Color fundus image — 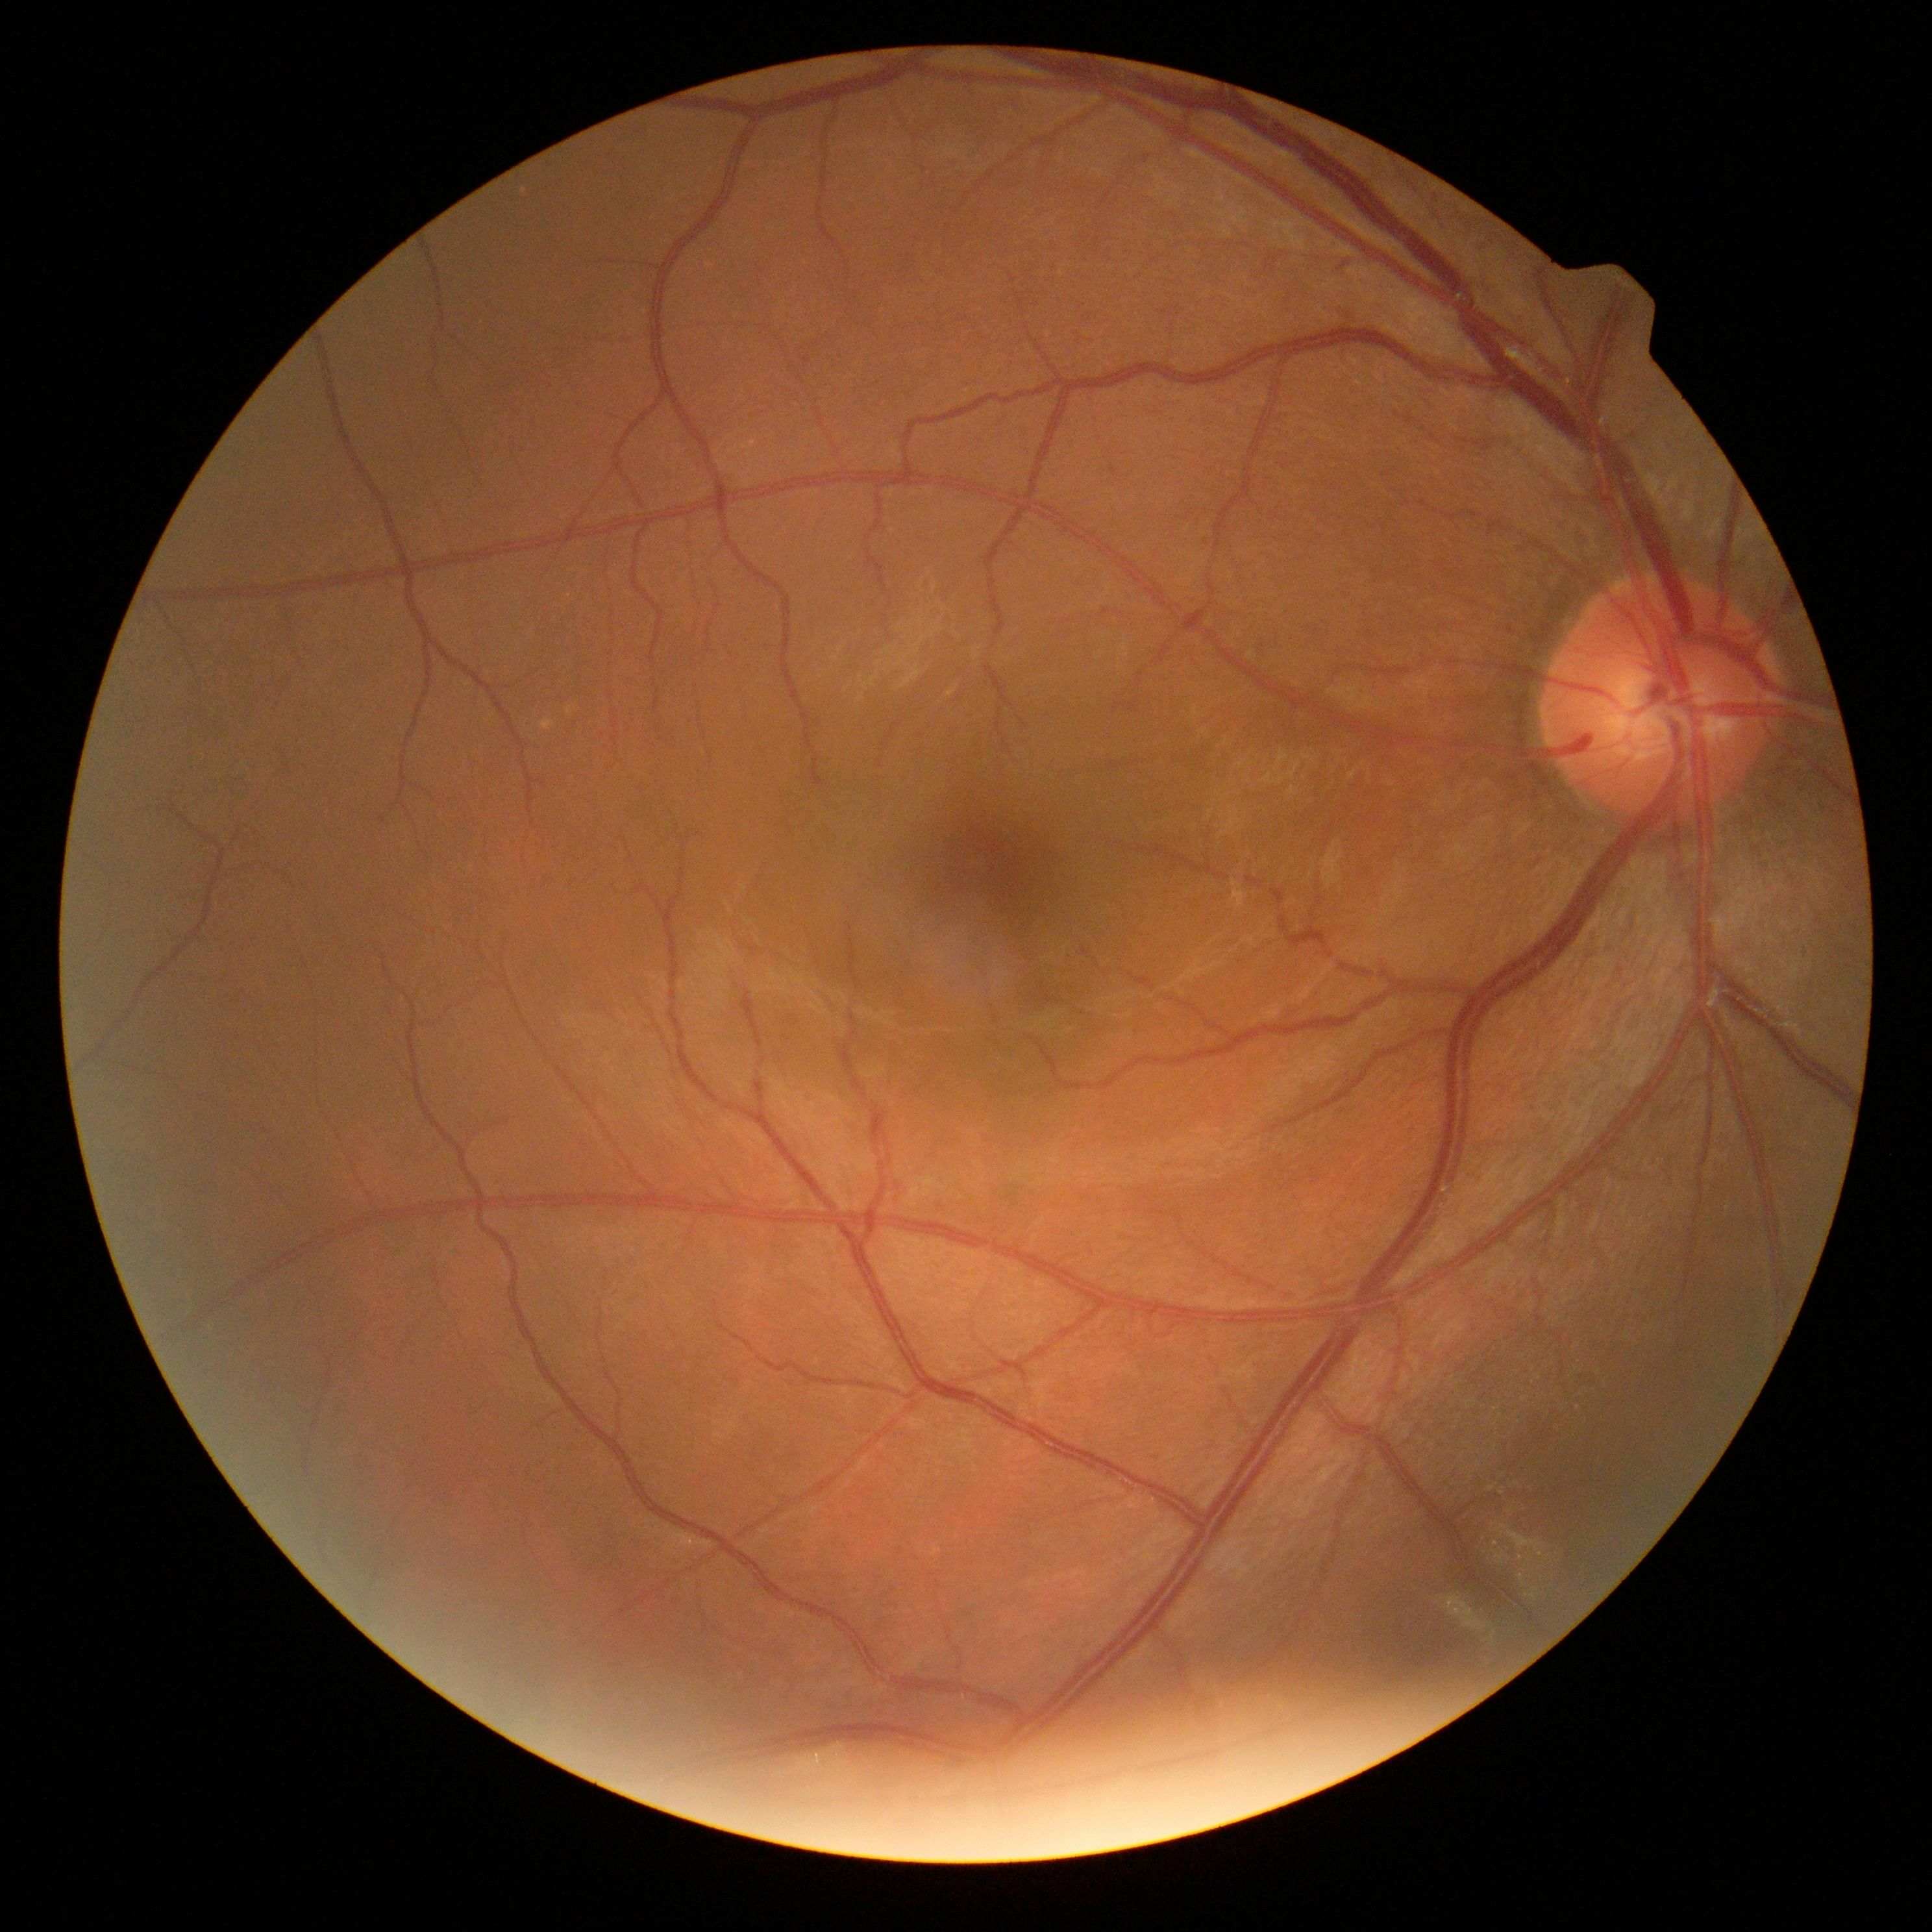

diabetic retinopathy (DR)@no apparent diabetic retinopathy (grade 0).